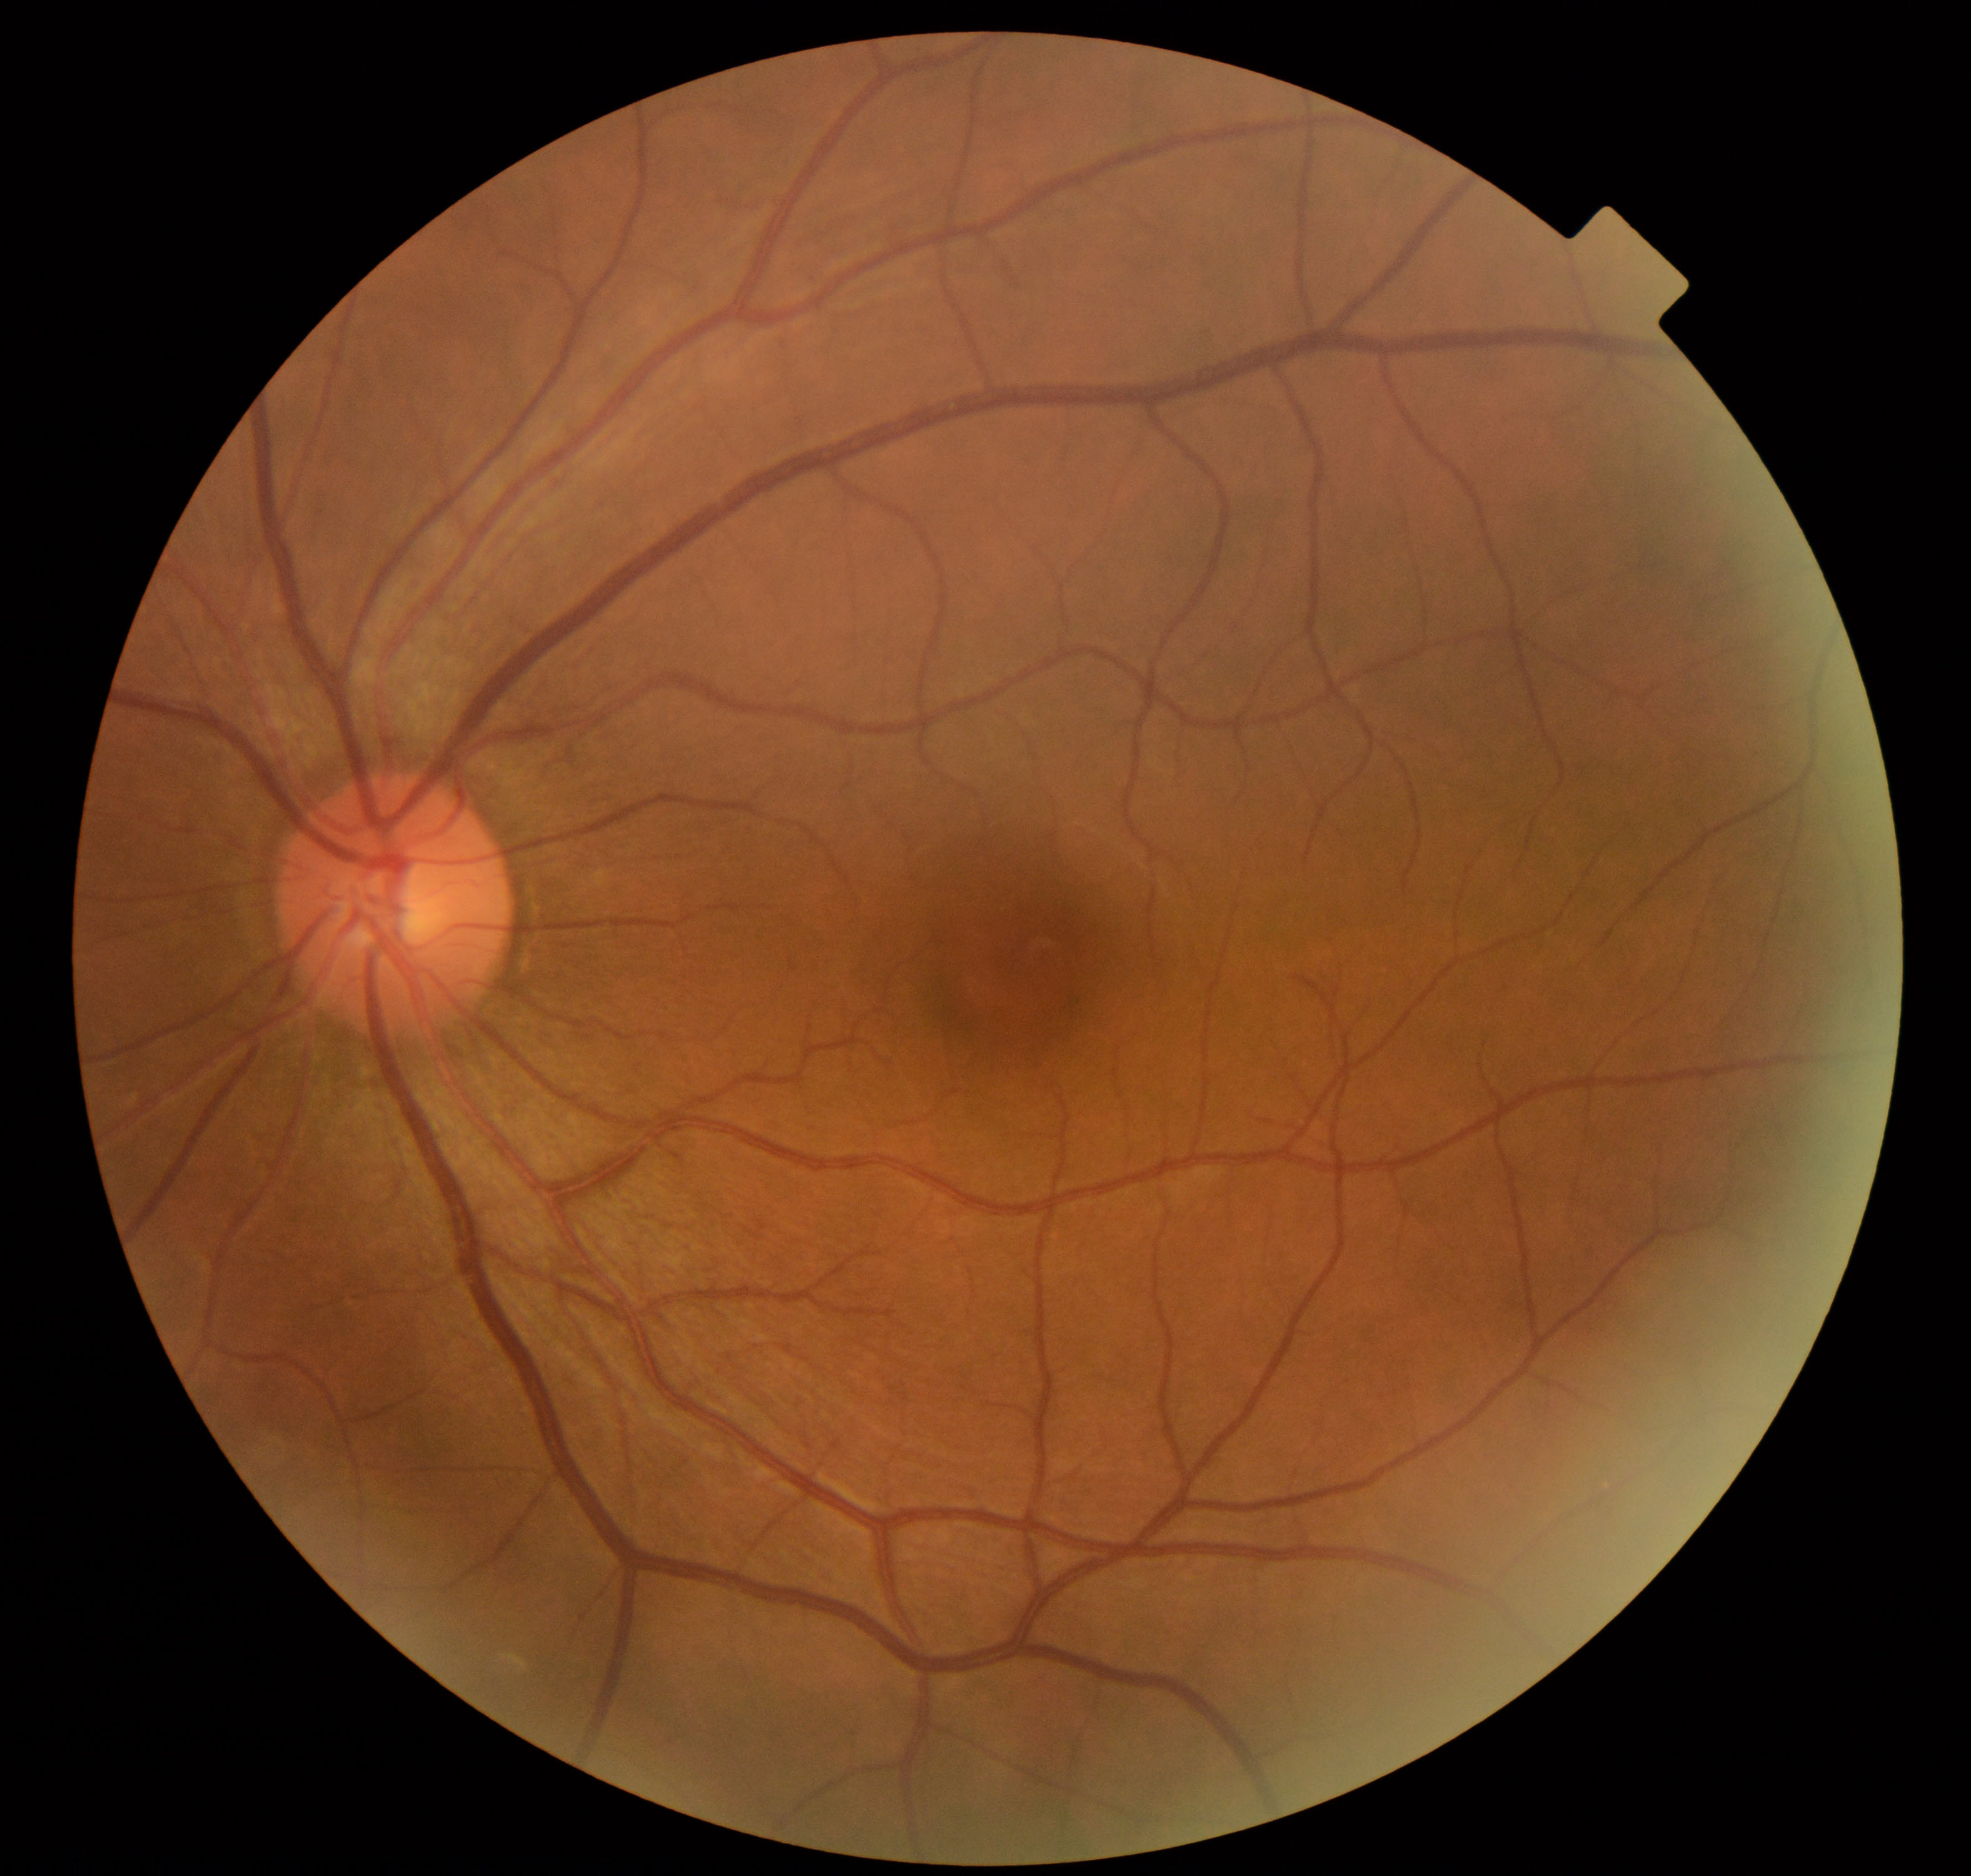

Normal fundus. No pathology identified.